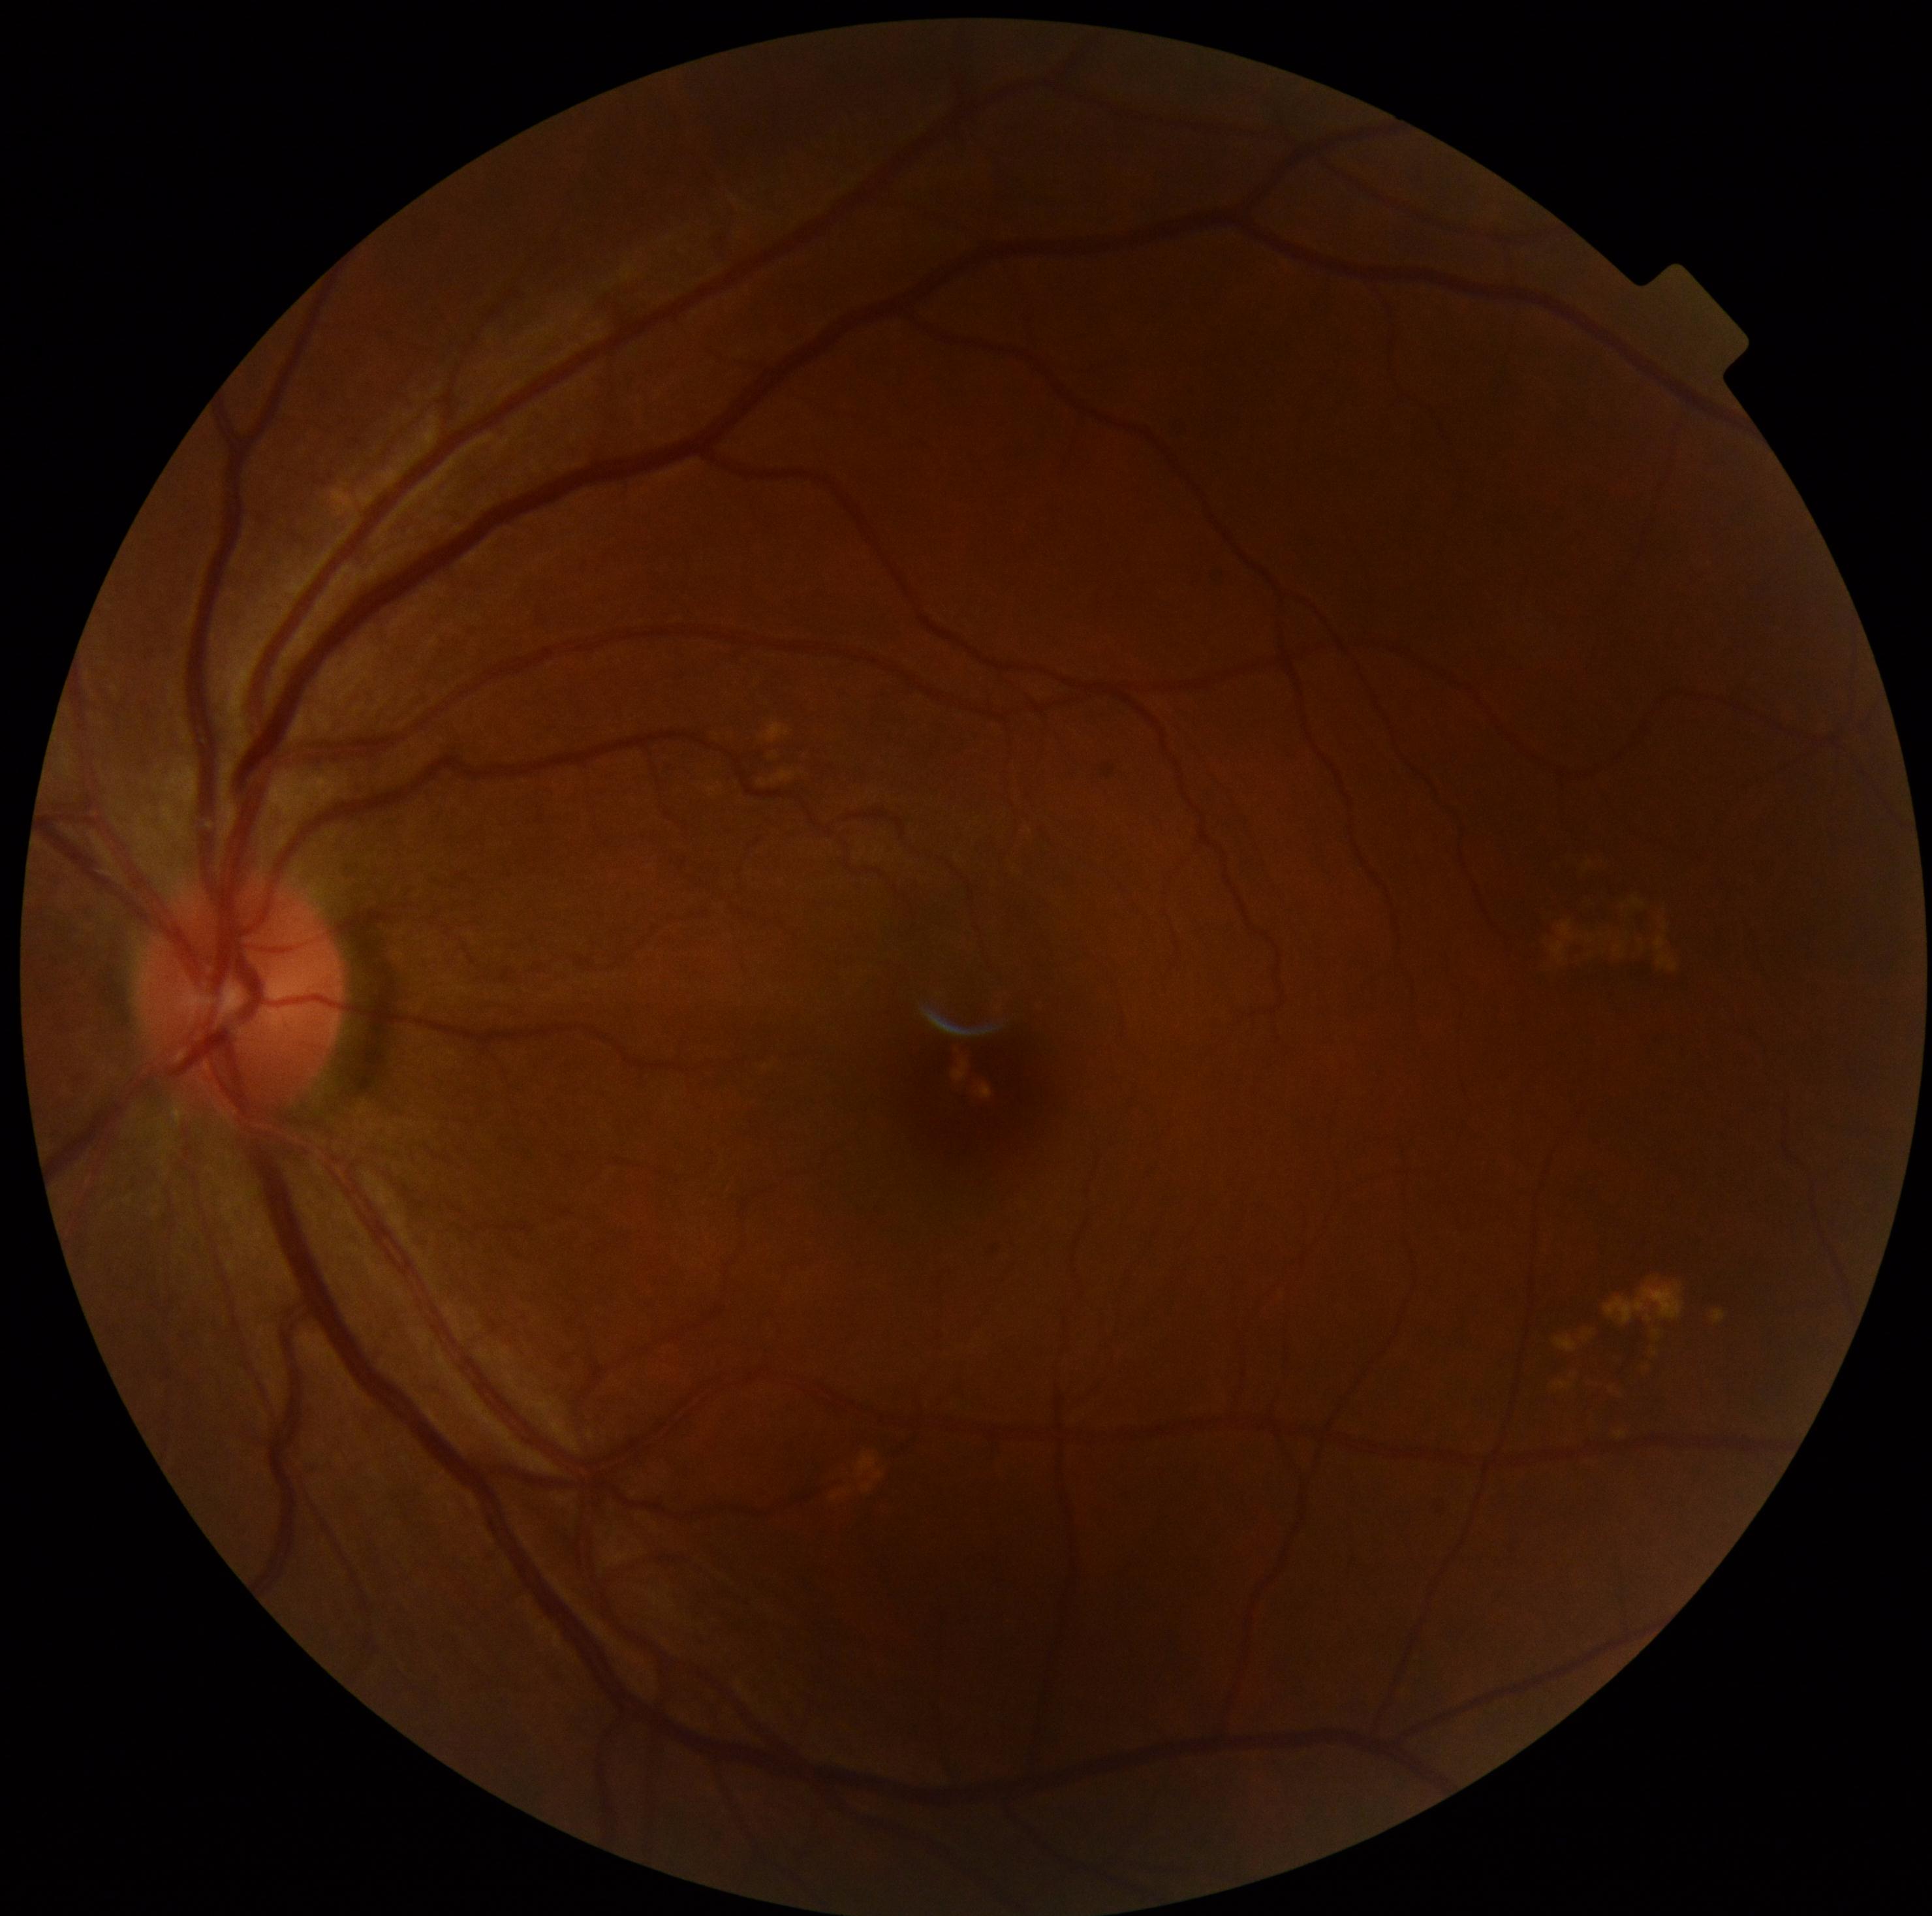 DR = grade 1 (mild NPDR).